NIDEK AFC-230. Diabetic retinopathy graded by the modified Davis classification
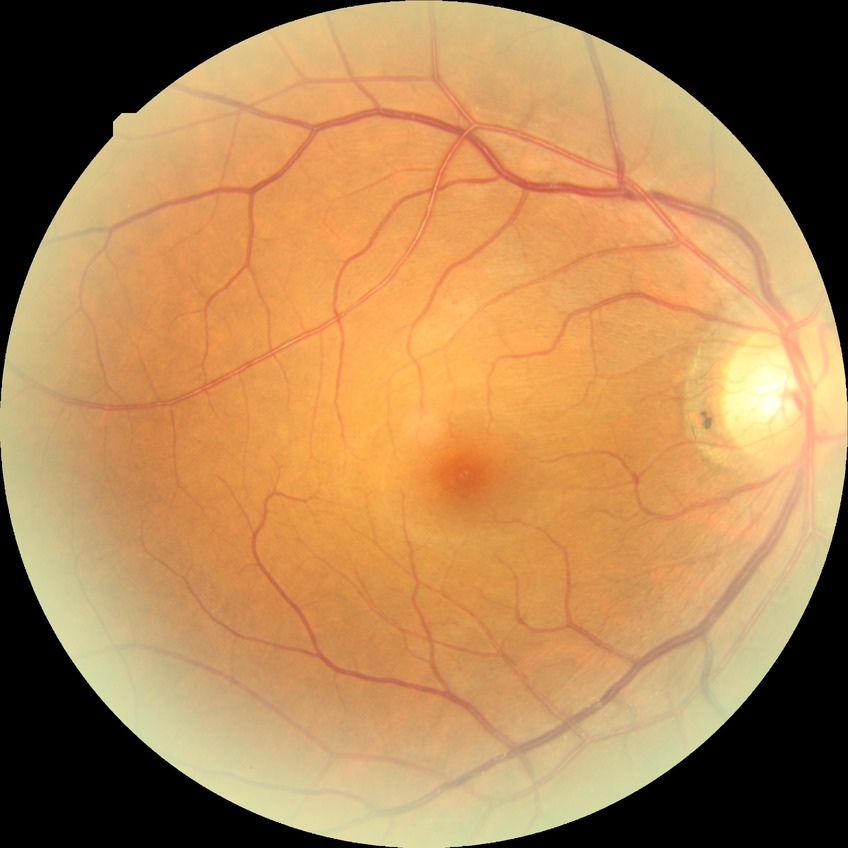

retinopathy stage: simple diabetic retinopathy.